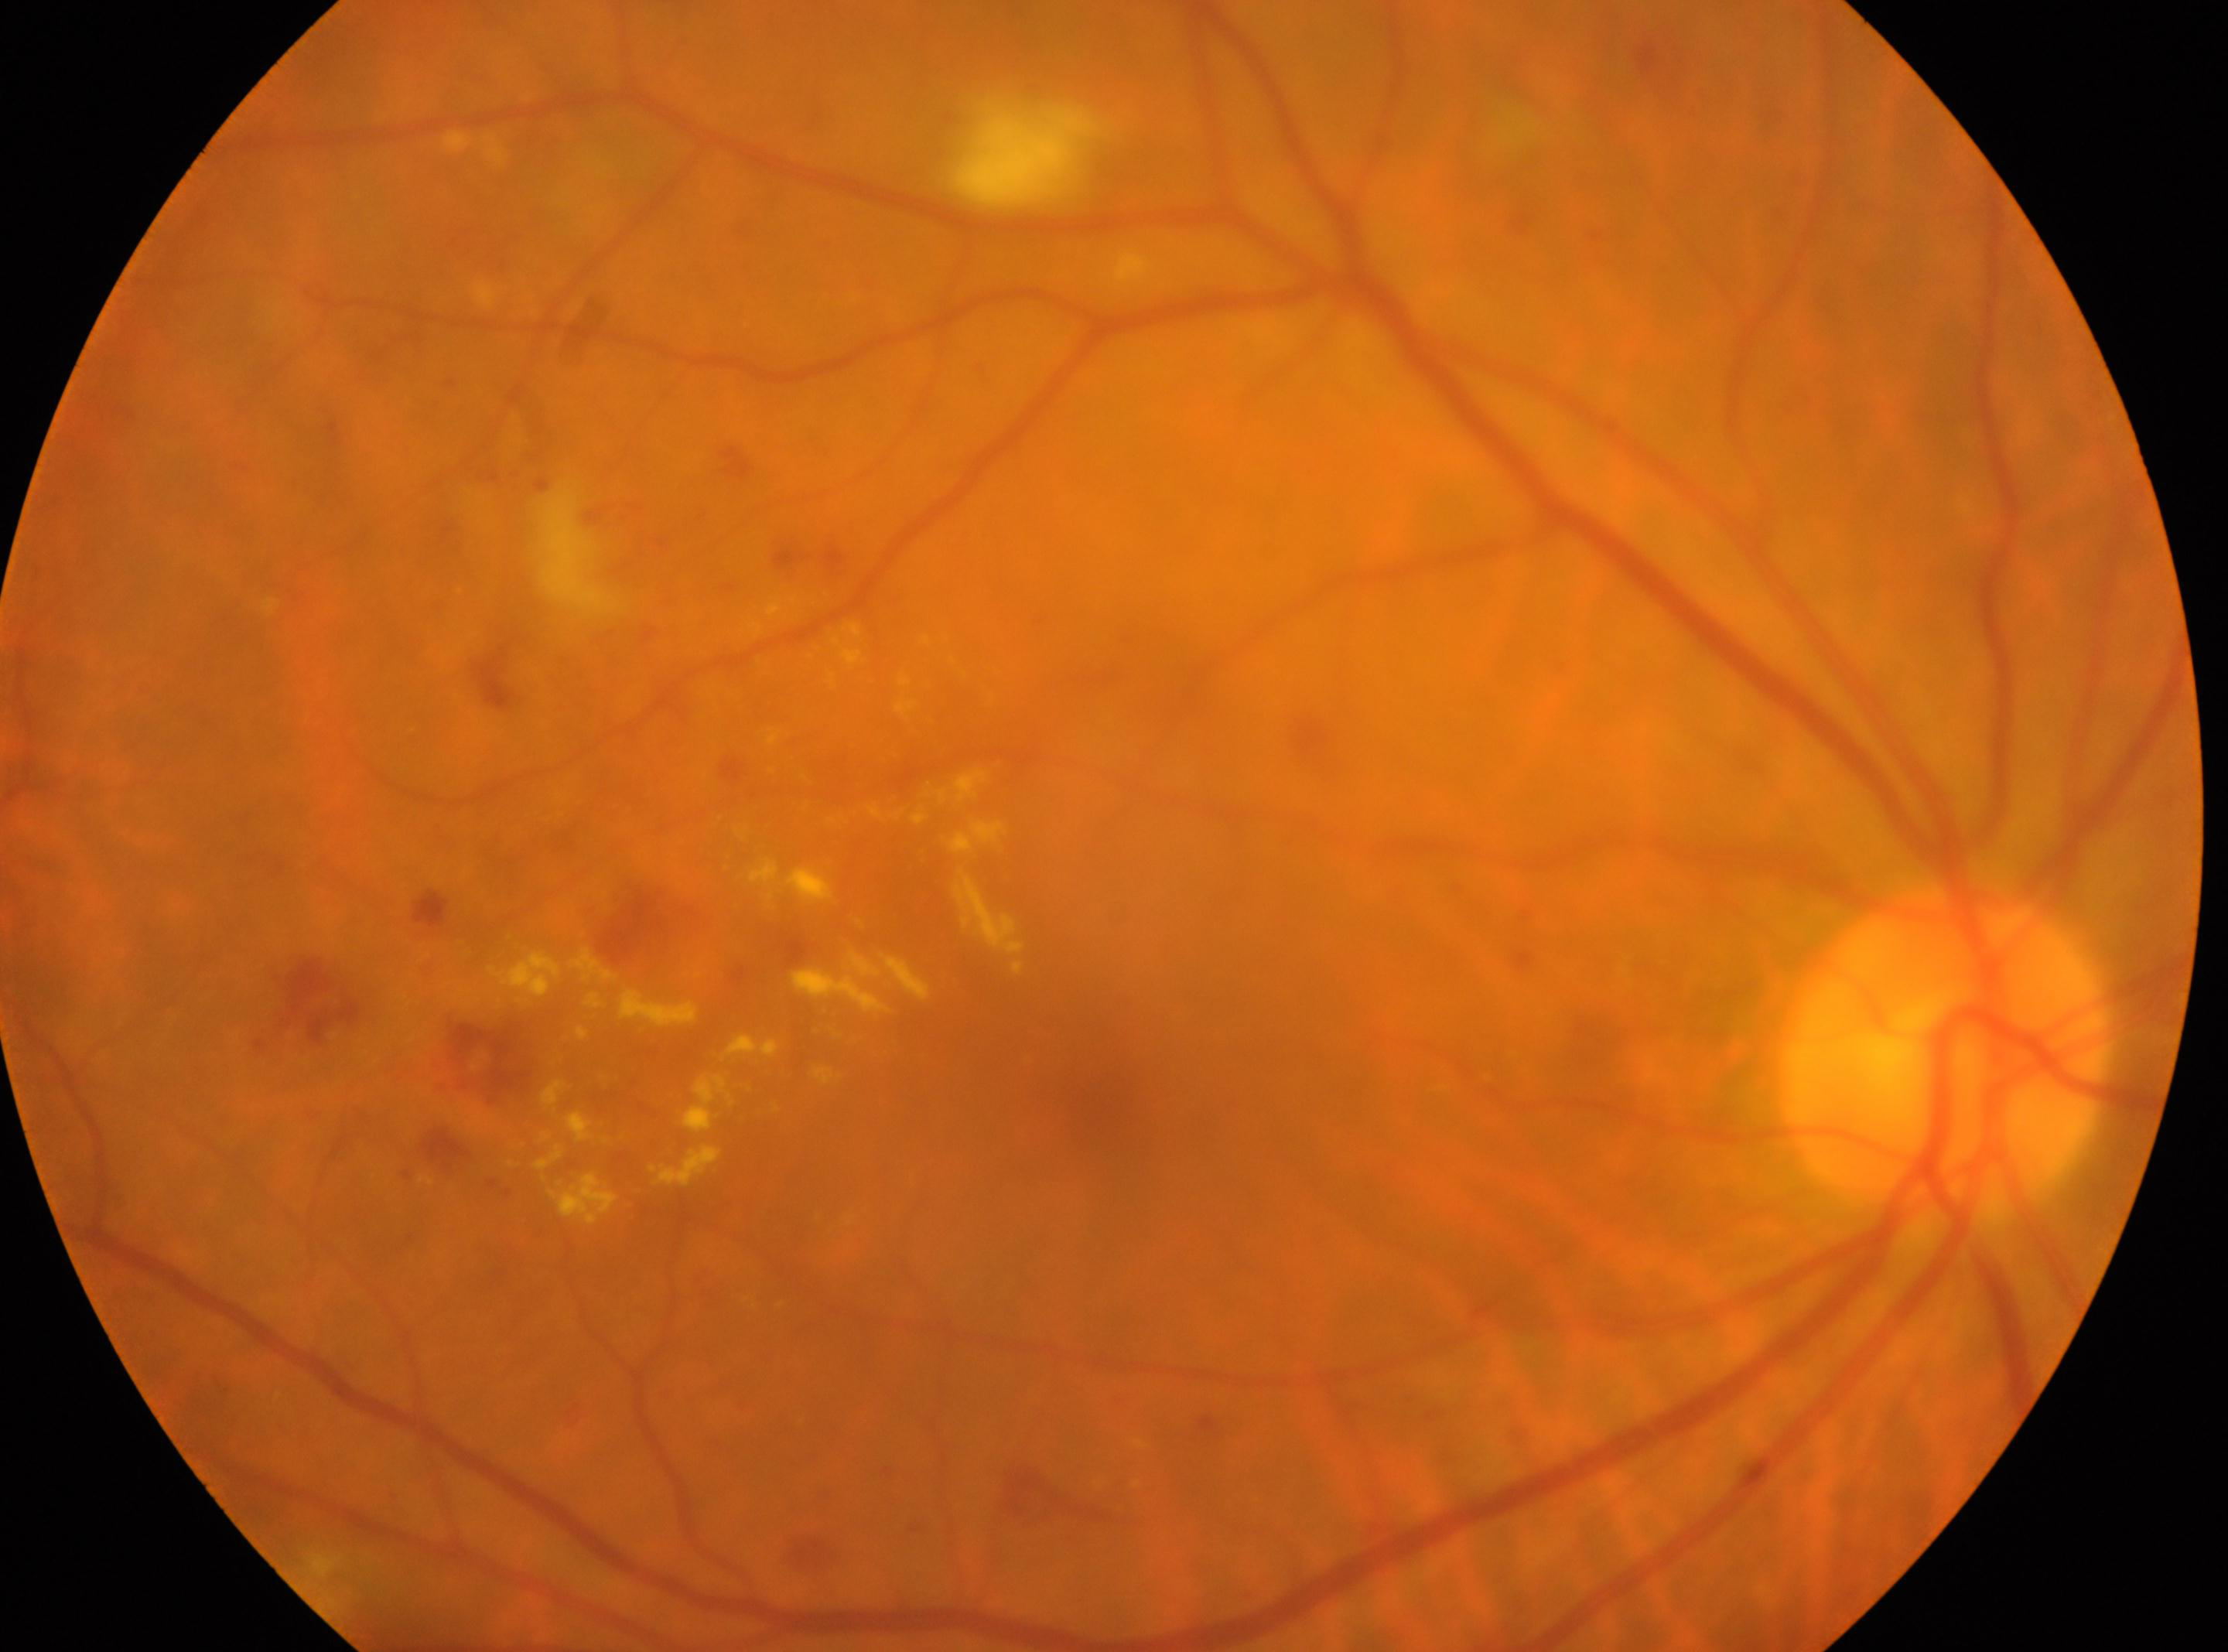 DR: grade 2 (moderate NPDR) | the optic disc: [1942, 1049] | laterality: the right eye | macula center: [1095, 1103].